Captured on a Nidek AFC-330 fundus camera; cropped to the optic nerve head:
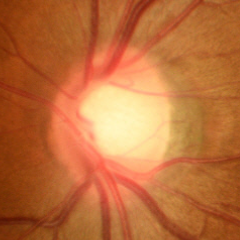

Q: Does this eye have glaucoma?
A: No glaucoma.